Davis DR grading
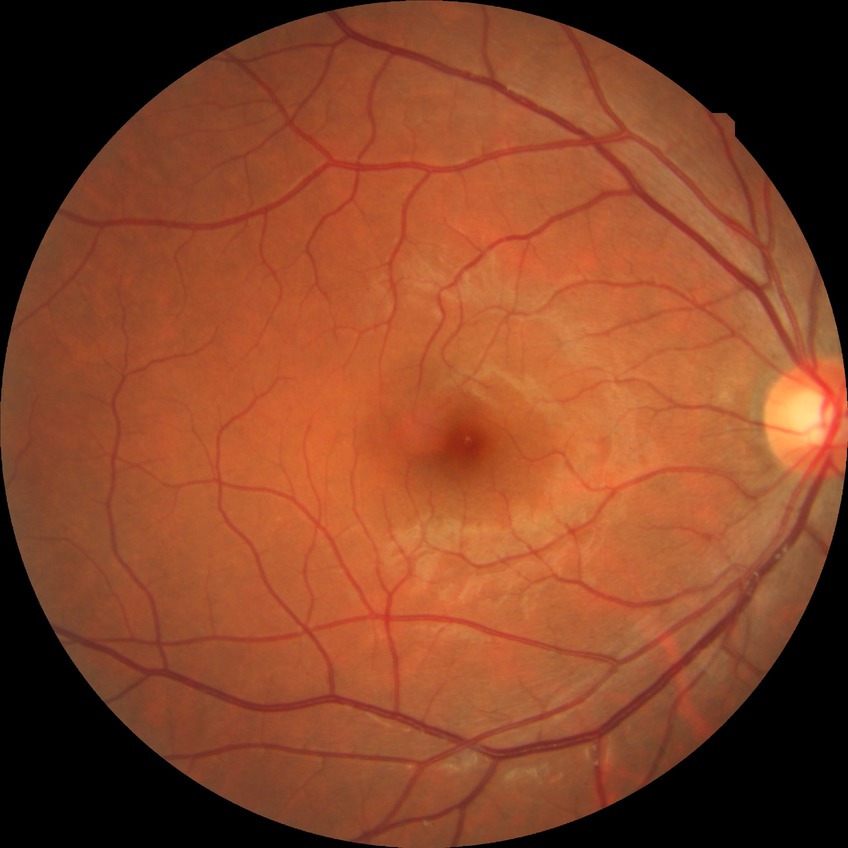 Diabetic retinopathy (DR) is NDR (no diabetic retinopathy).